Retinal fundus photograph. FOV: 30 degrees. Optic disc at the center of the field:
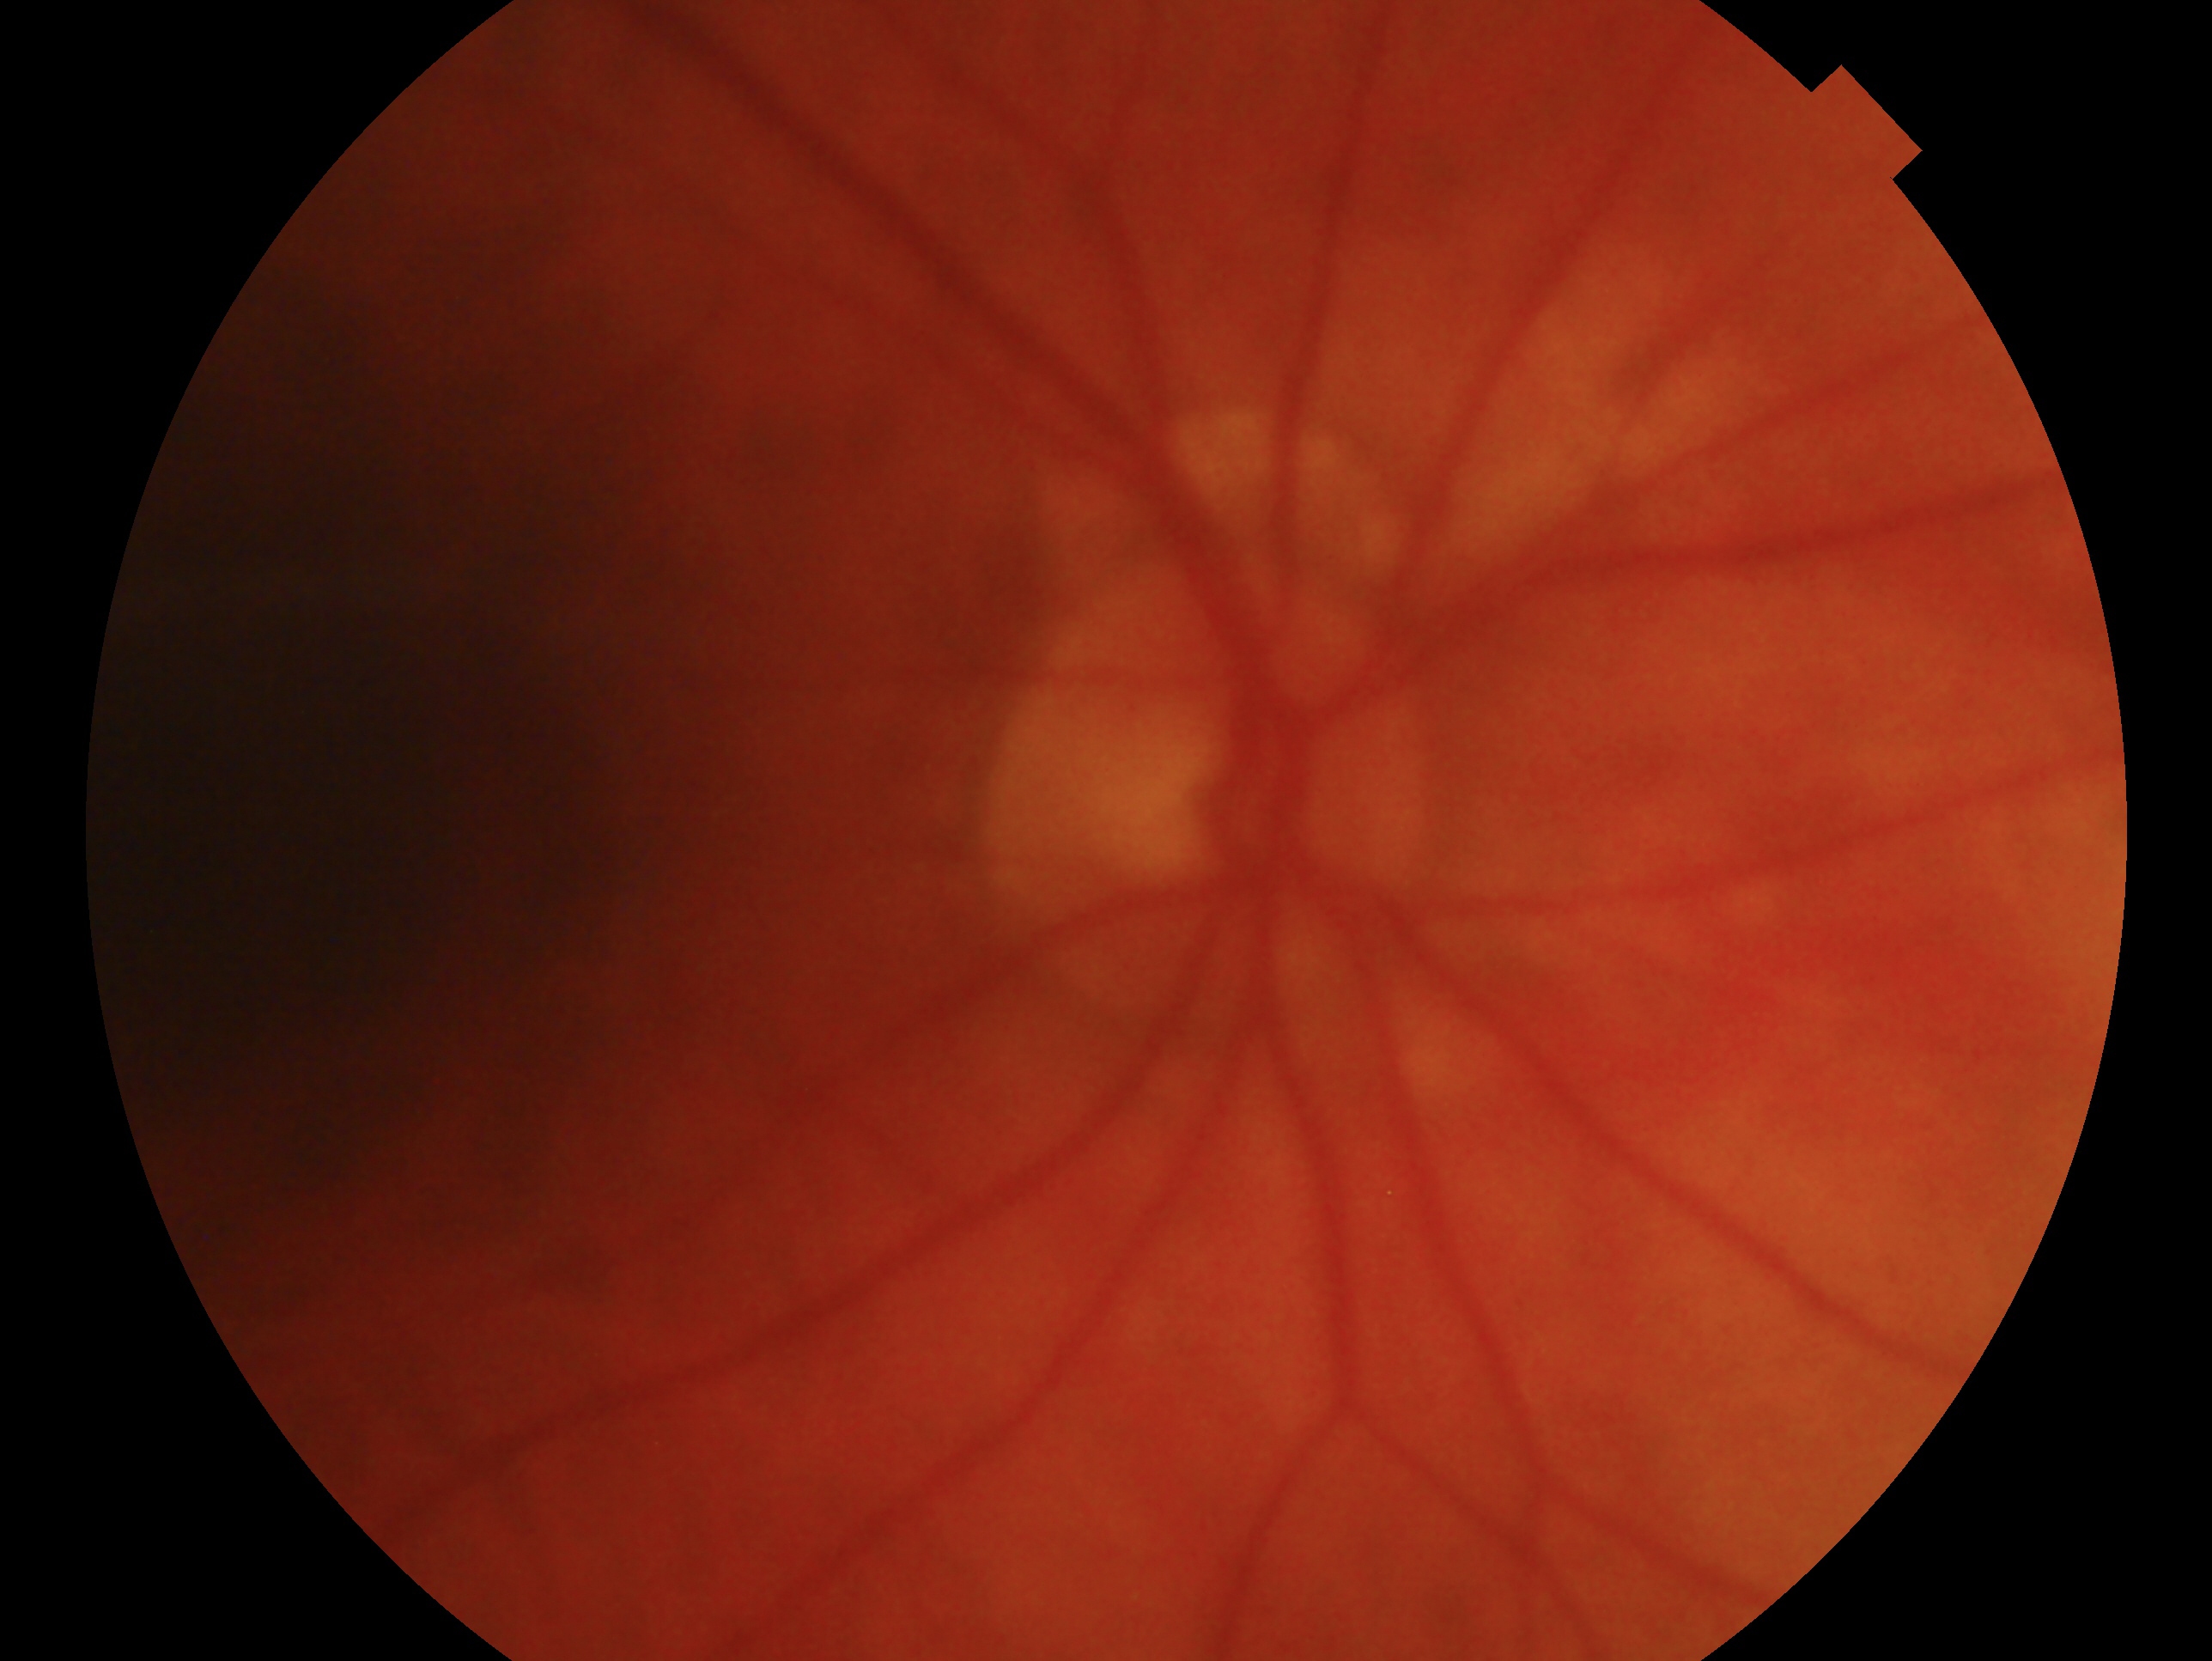

glaucoma_dx: no glaucomatous findings
eye: OD